1932x1932px. 45° field of view. Color fundus photograph:
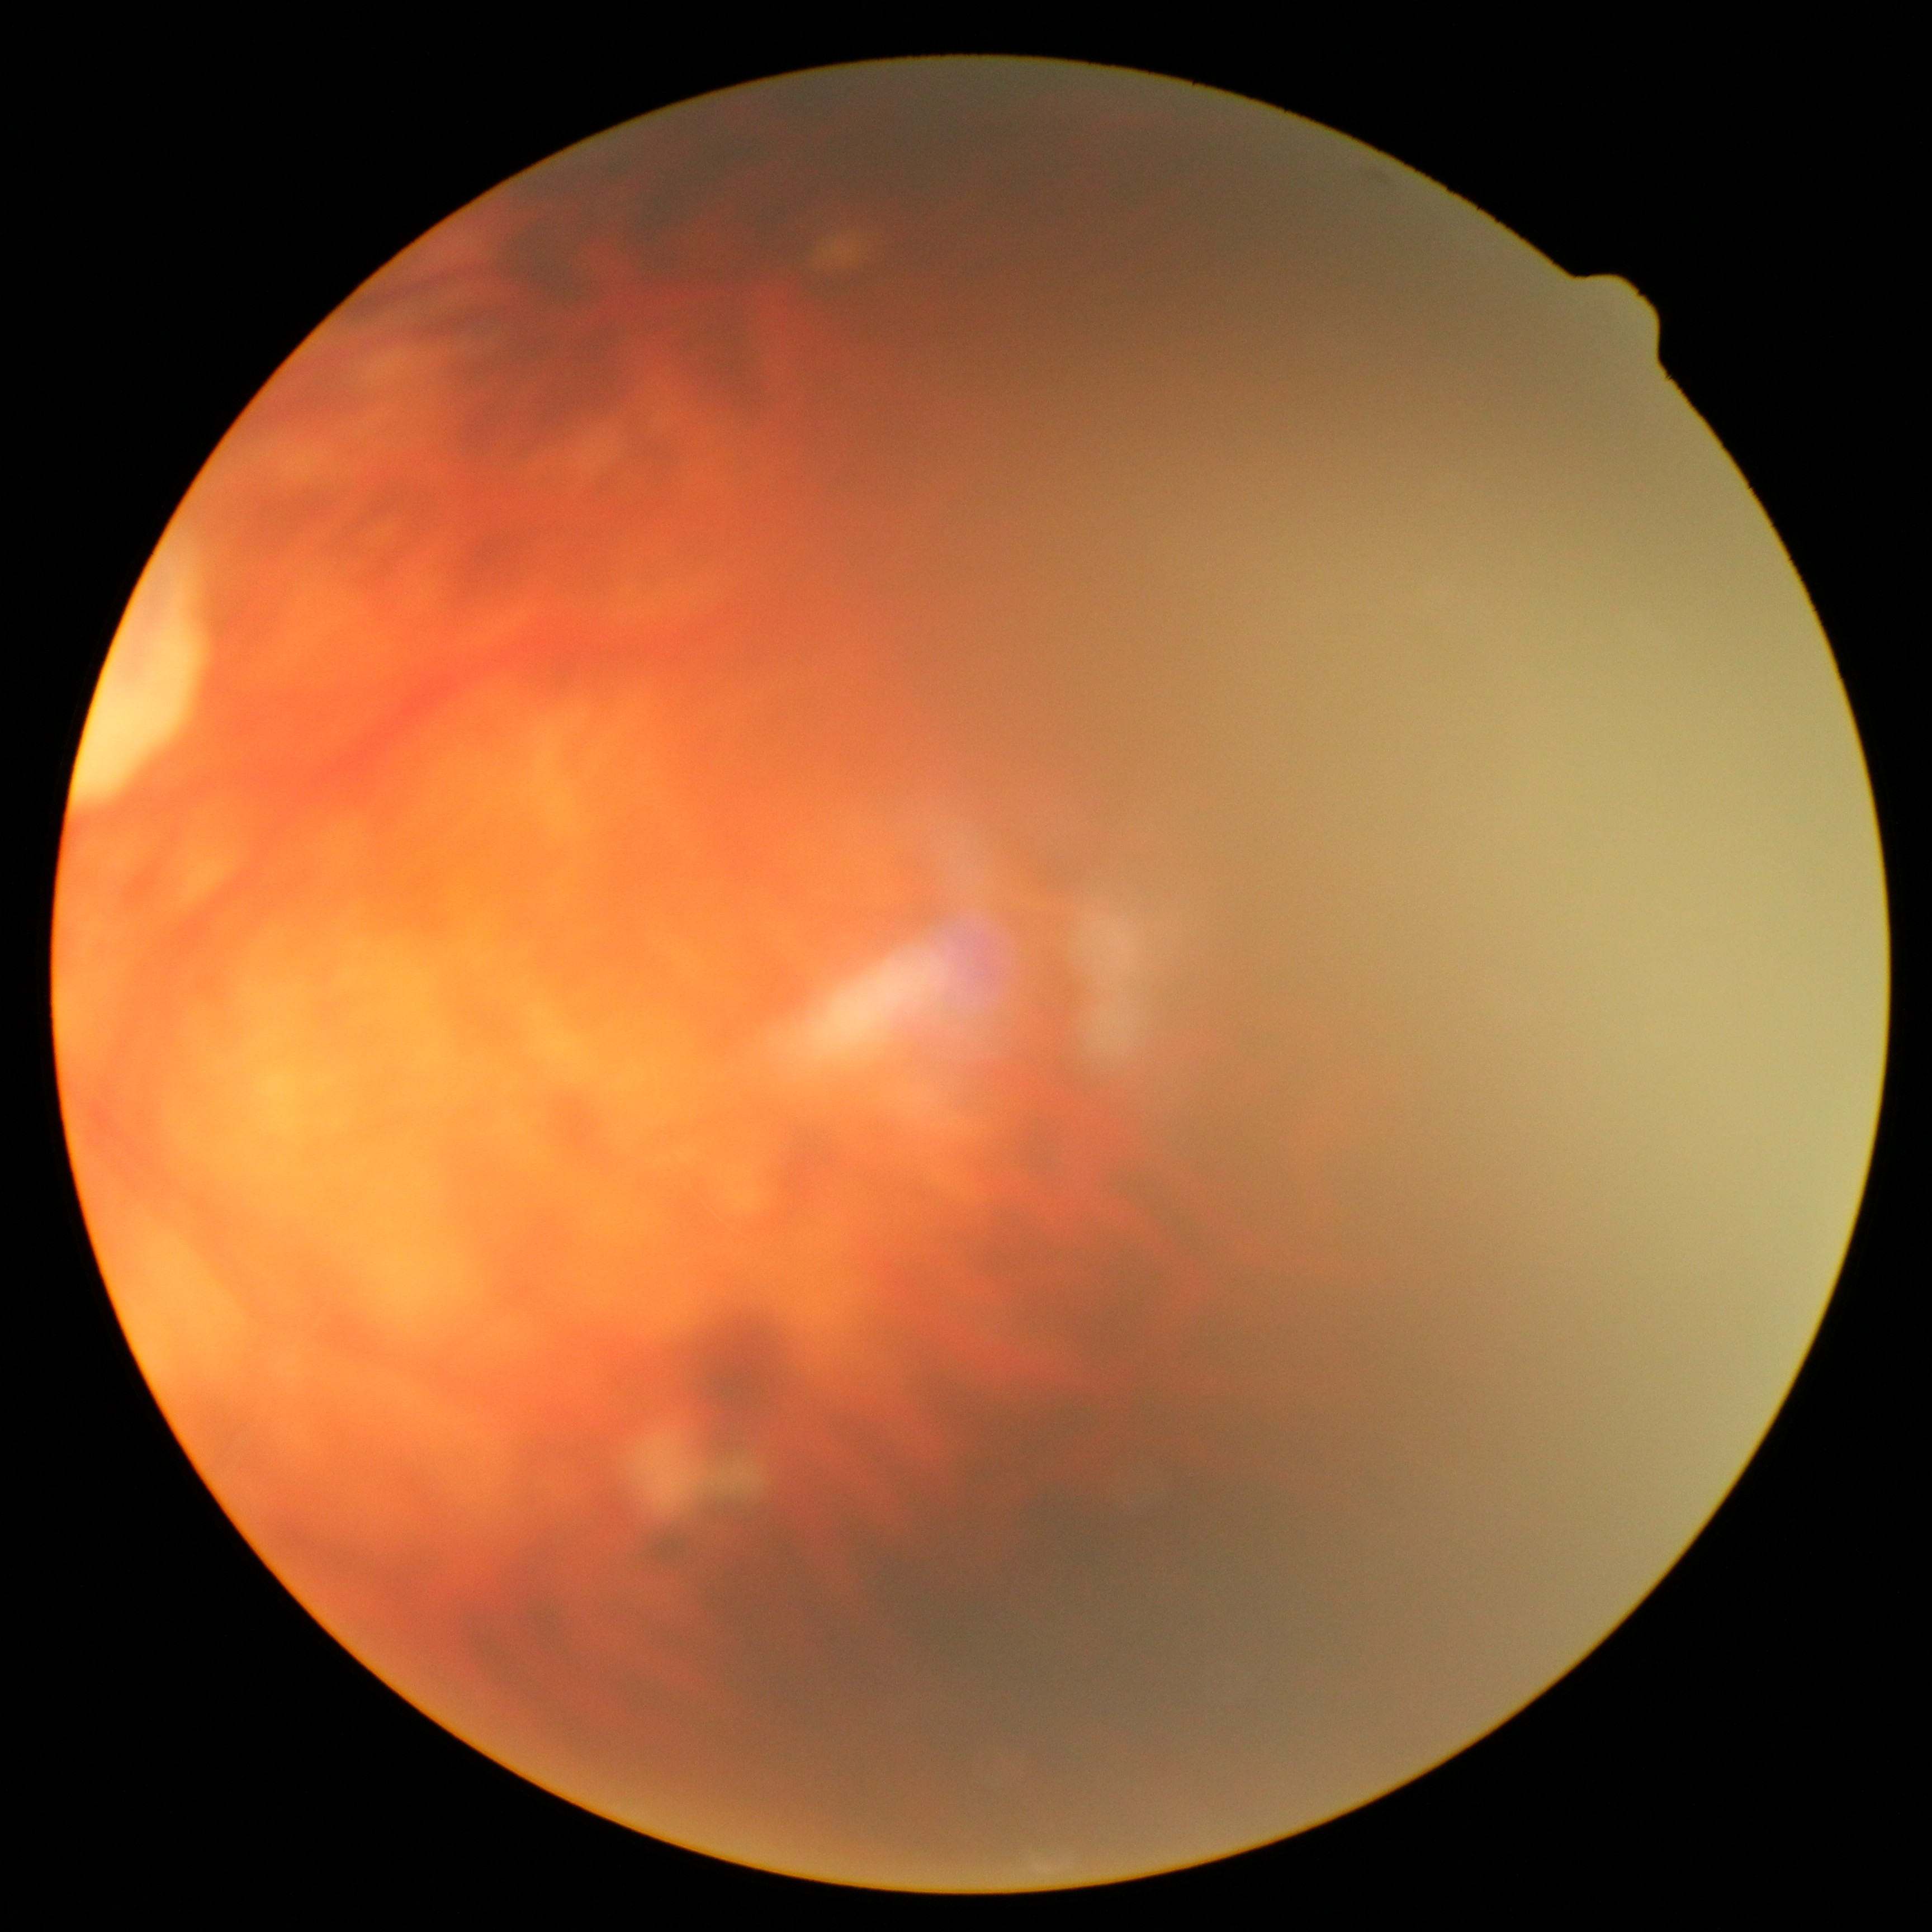 Annotations:
• retinopathy — ungradable due to poor image quality